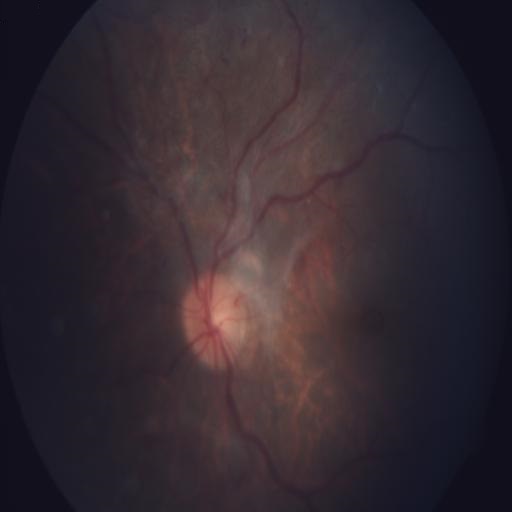
2 abnormalities. Retinal fundus photograph demonstrating TV (tortuous vessels) and TSLN (tessellation).